Image size 2352x1568, FOV: 45 degrees — 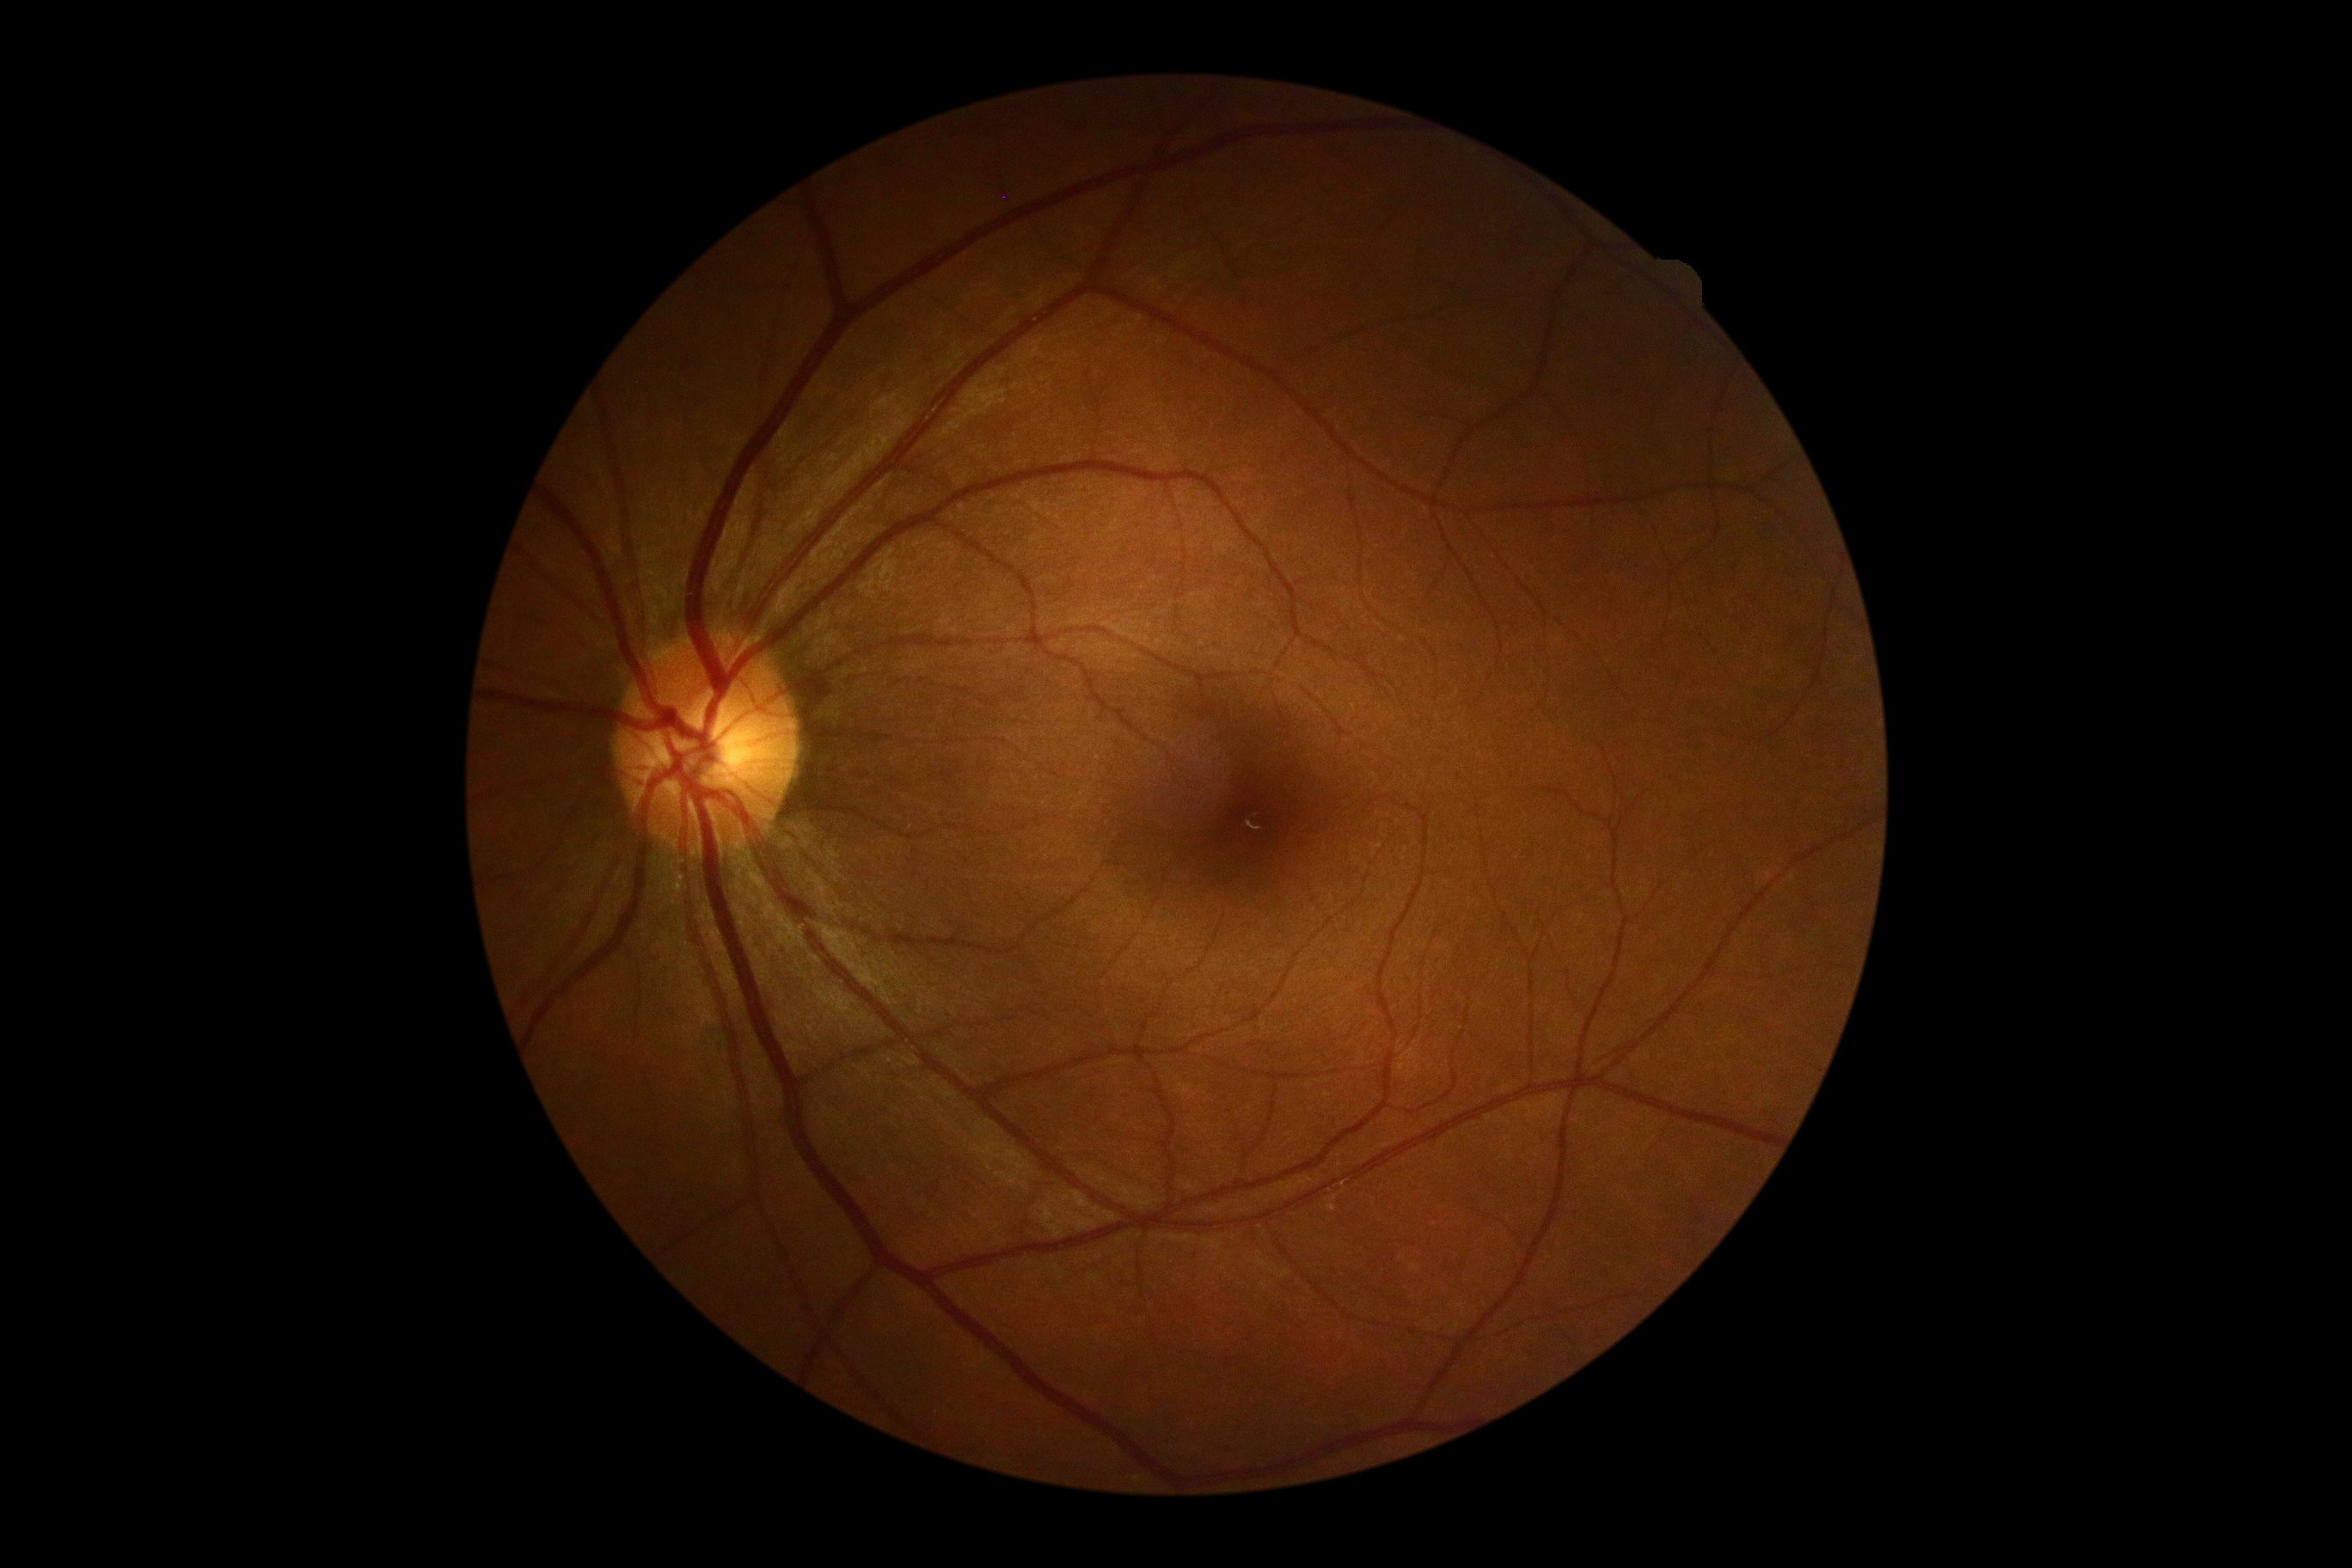 diabetic retinopathy severity: grade 0 (no apparent retinopathy).